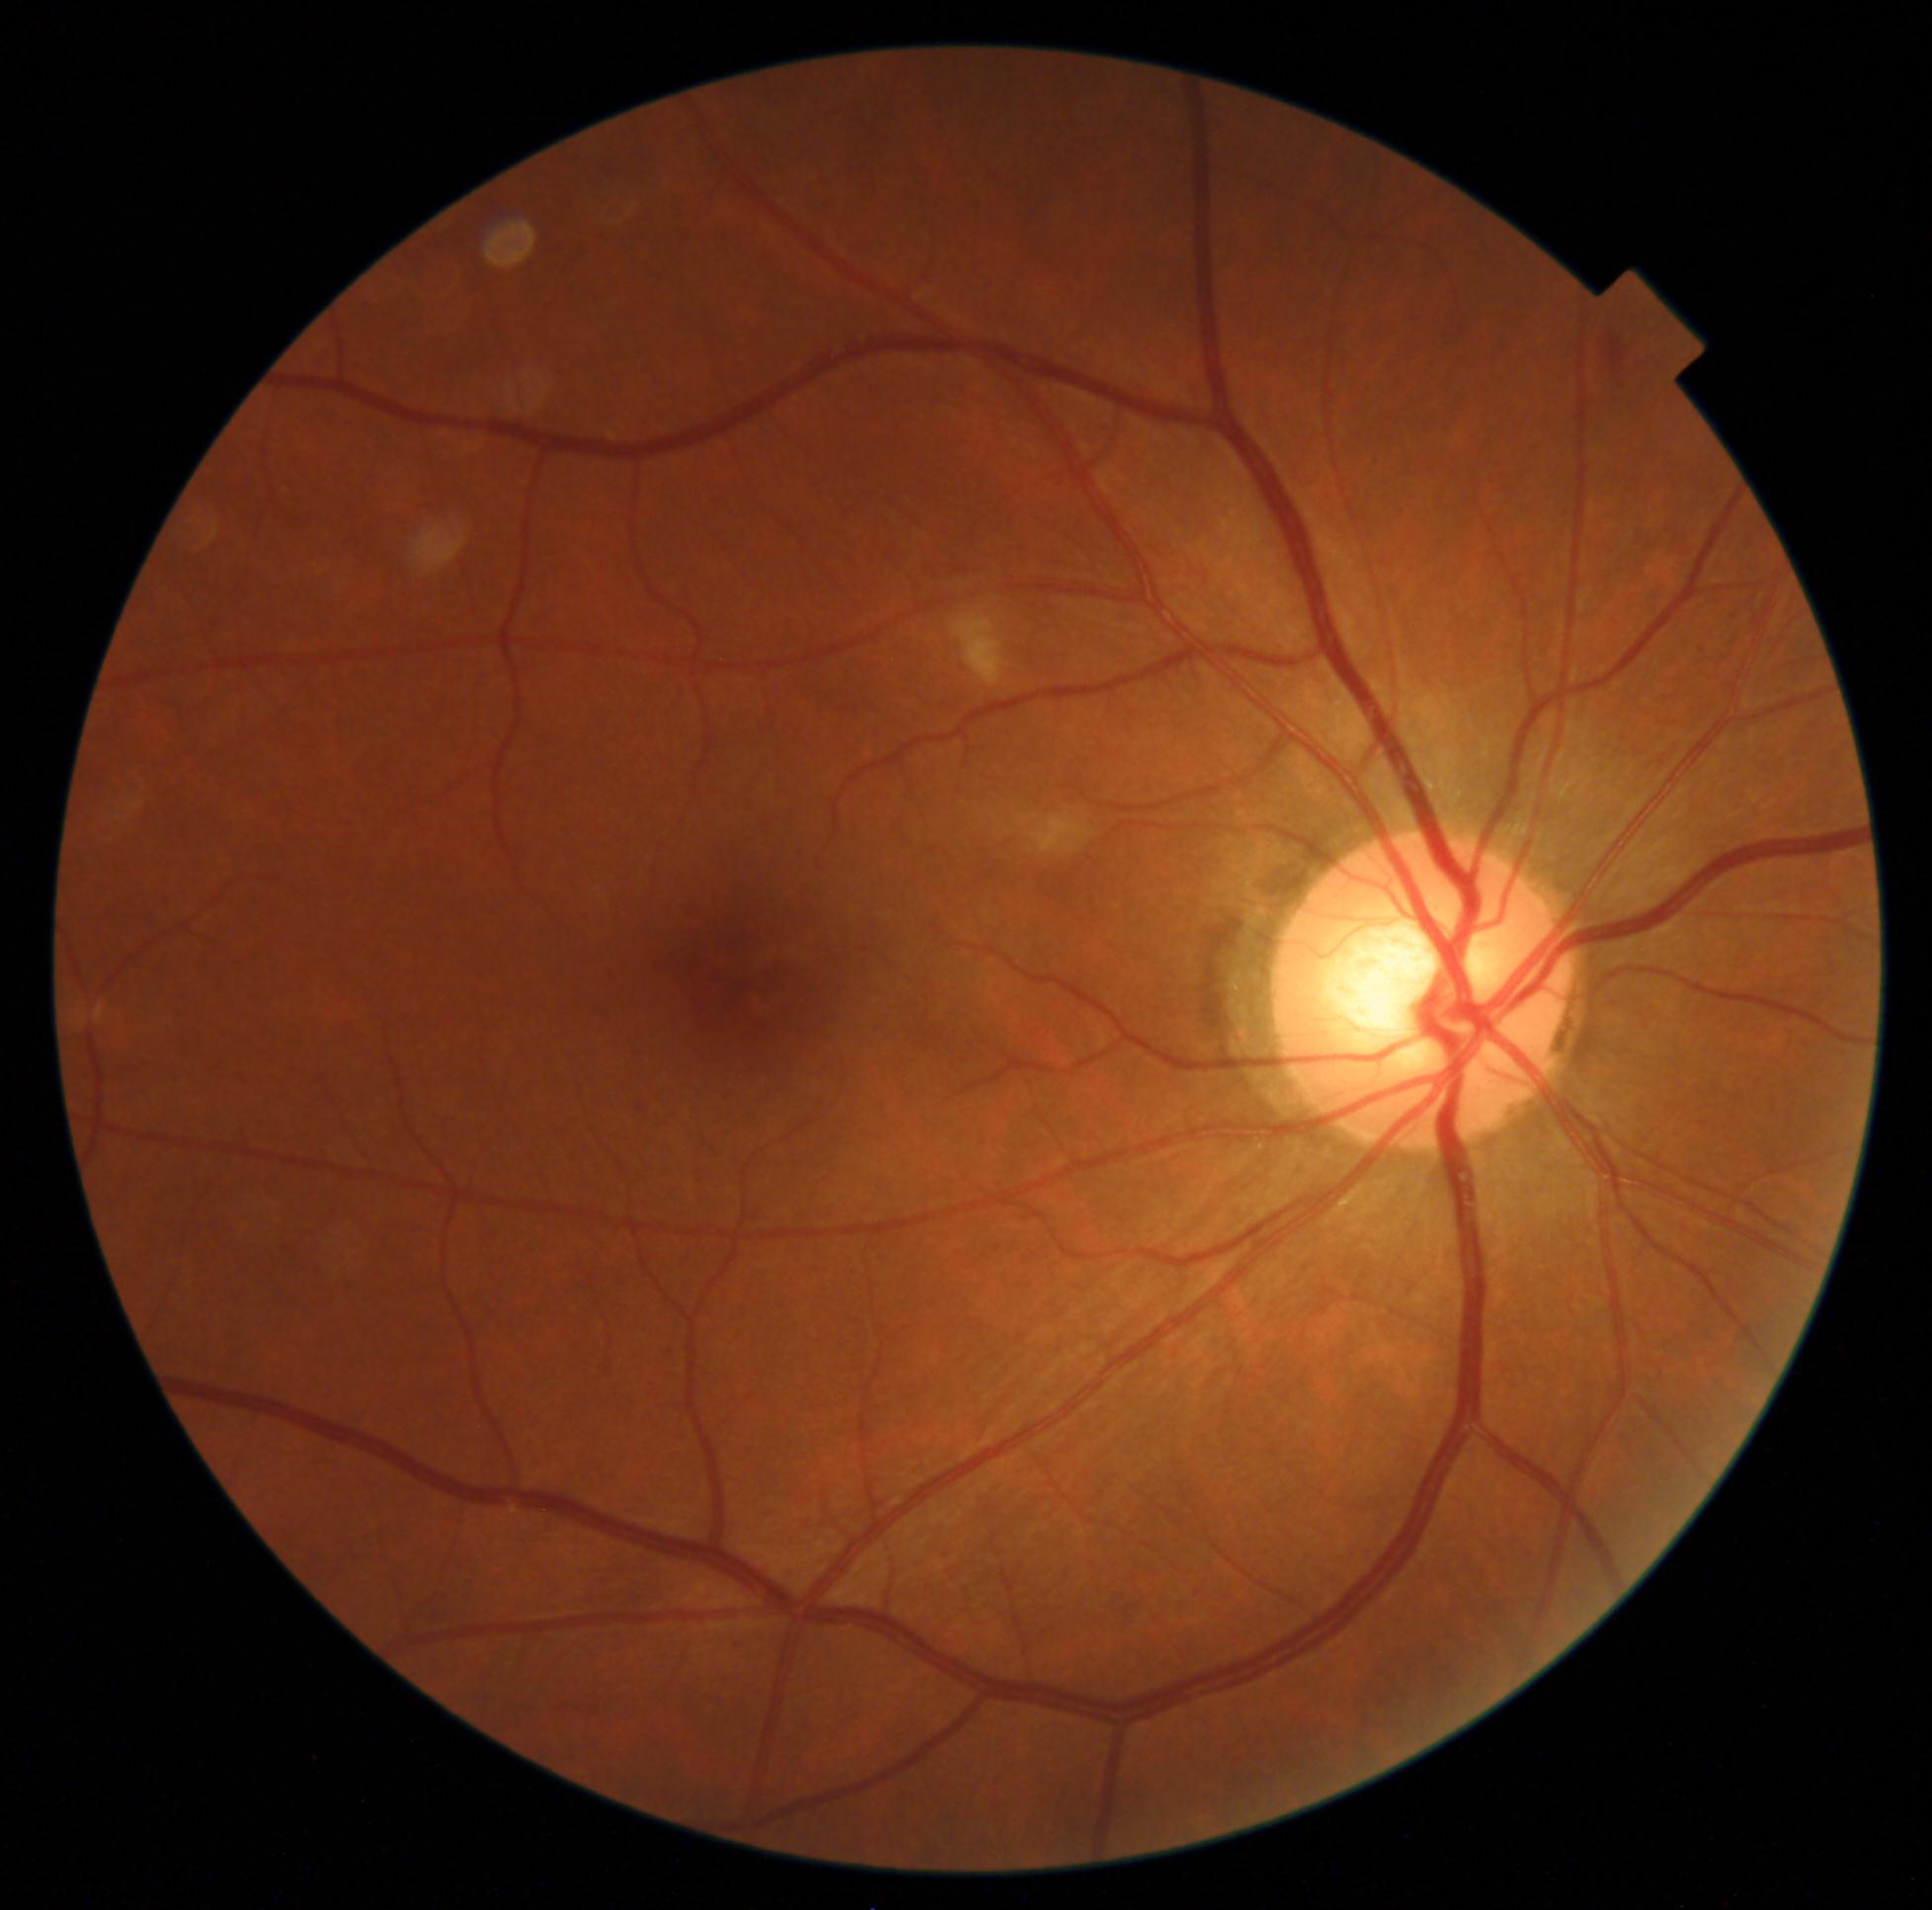 Diabetic retinopathy (DR): 2/4 — more than just microaneurysms but less than severe NPDR.